2048x1536px.
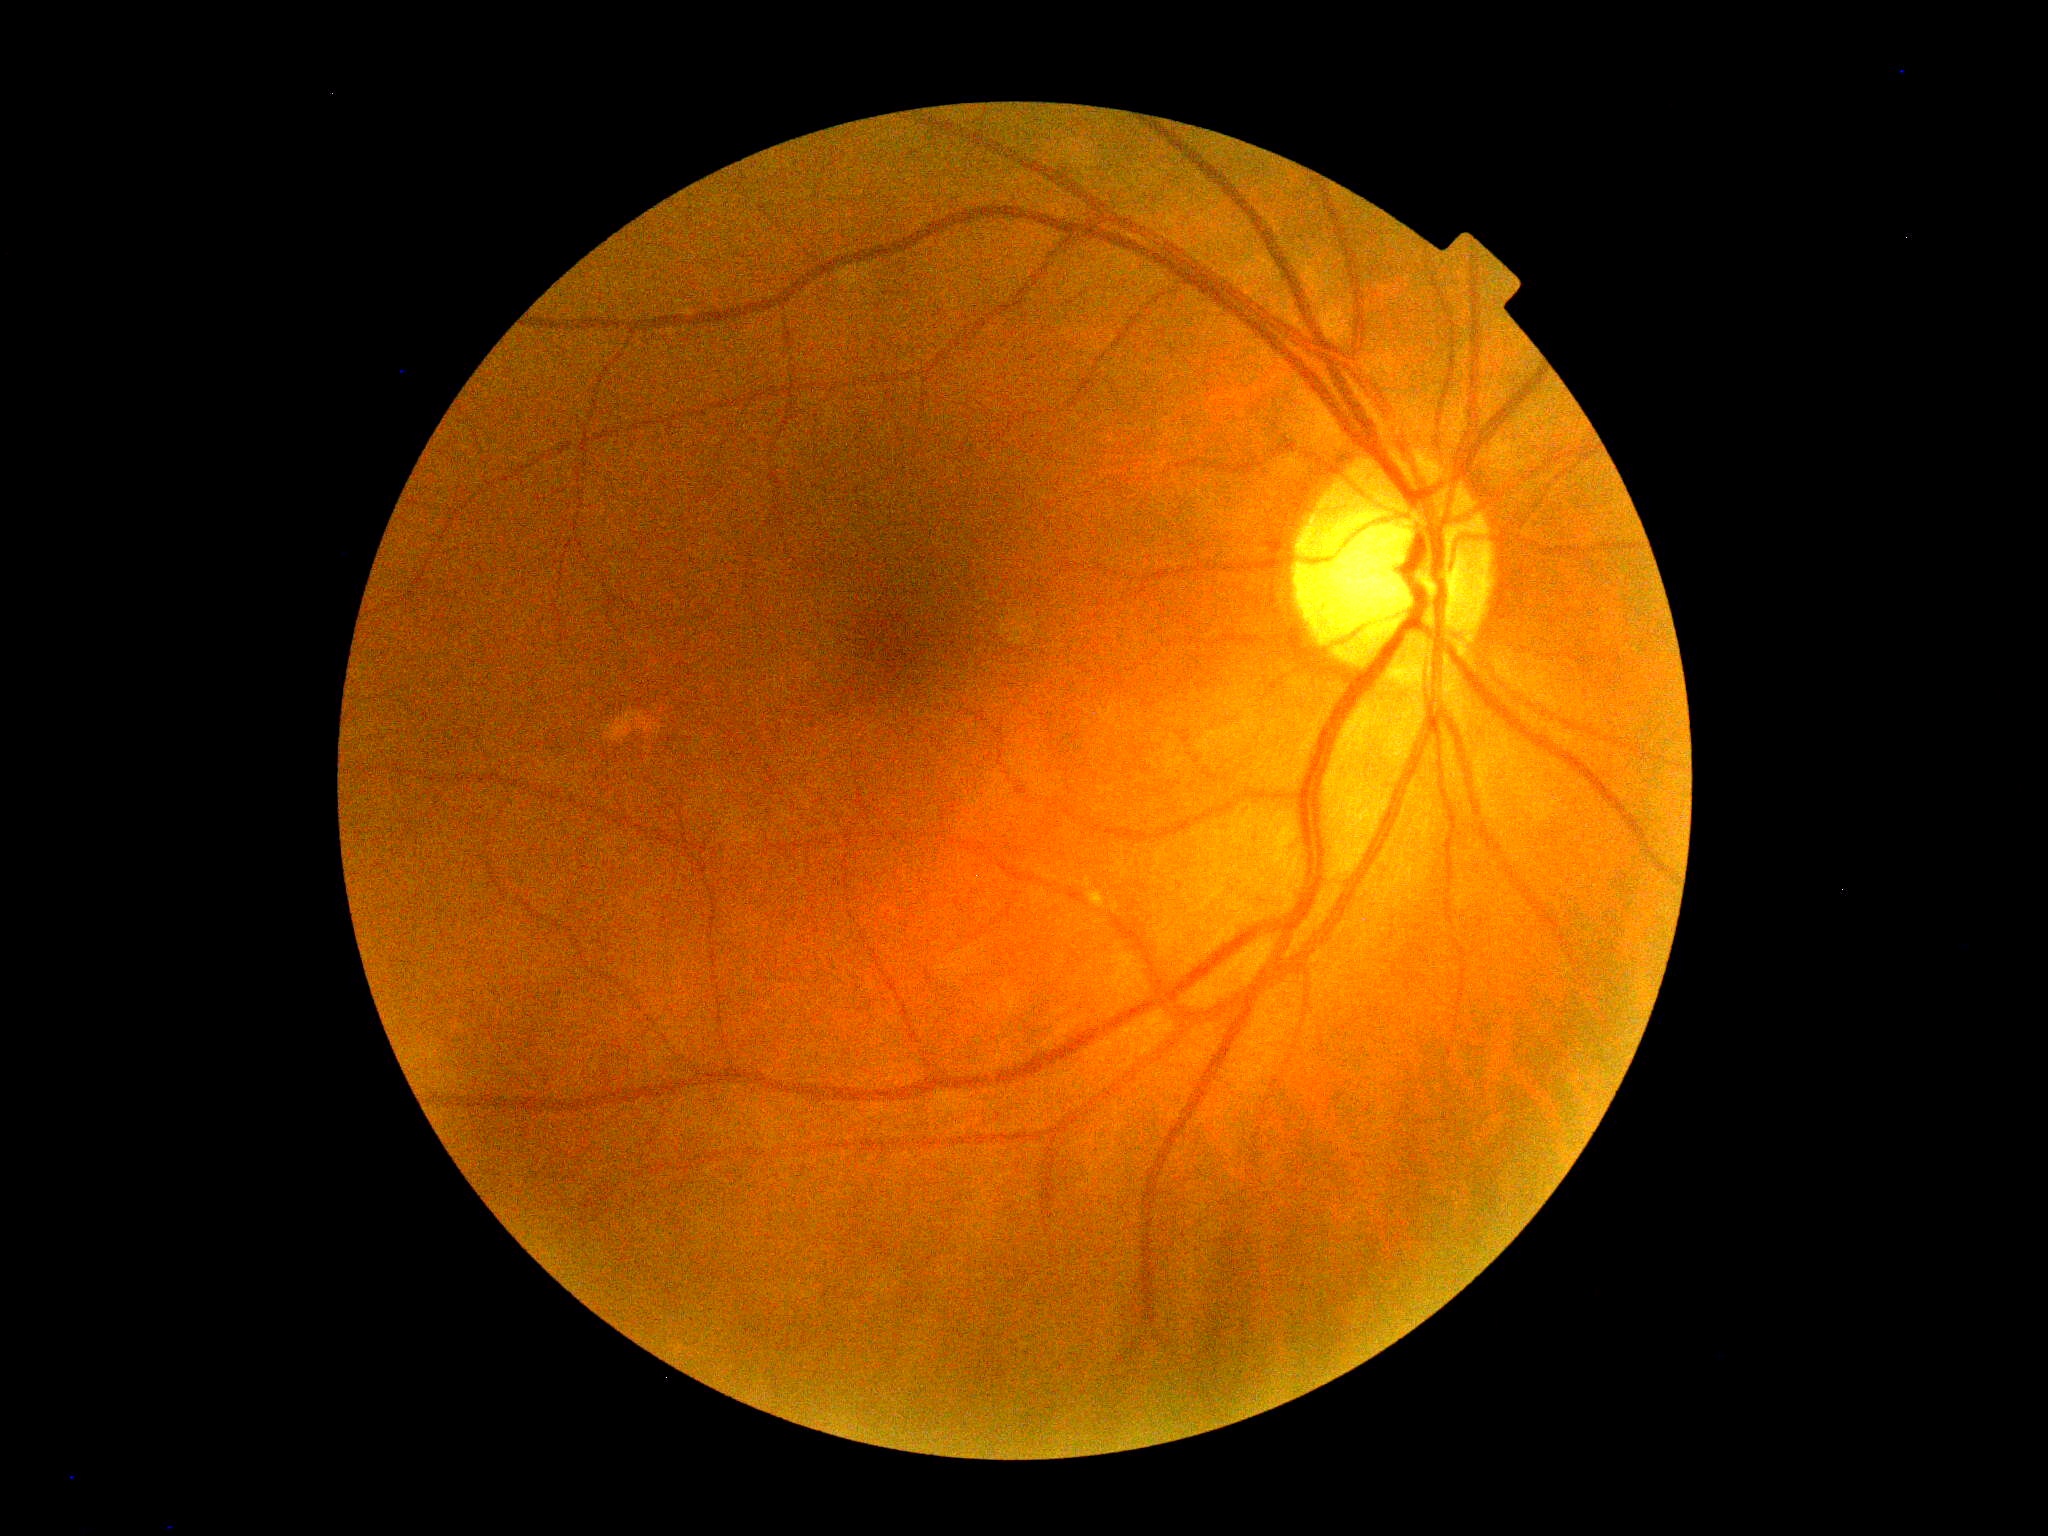
Retinopathy grade: 0.